2346 by 1568 pixels
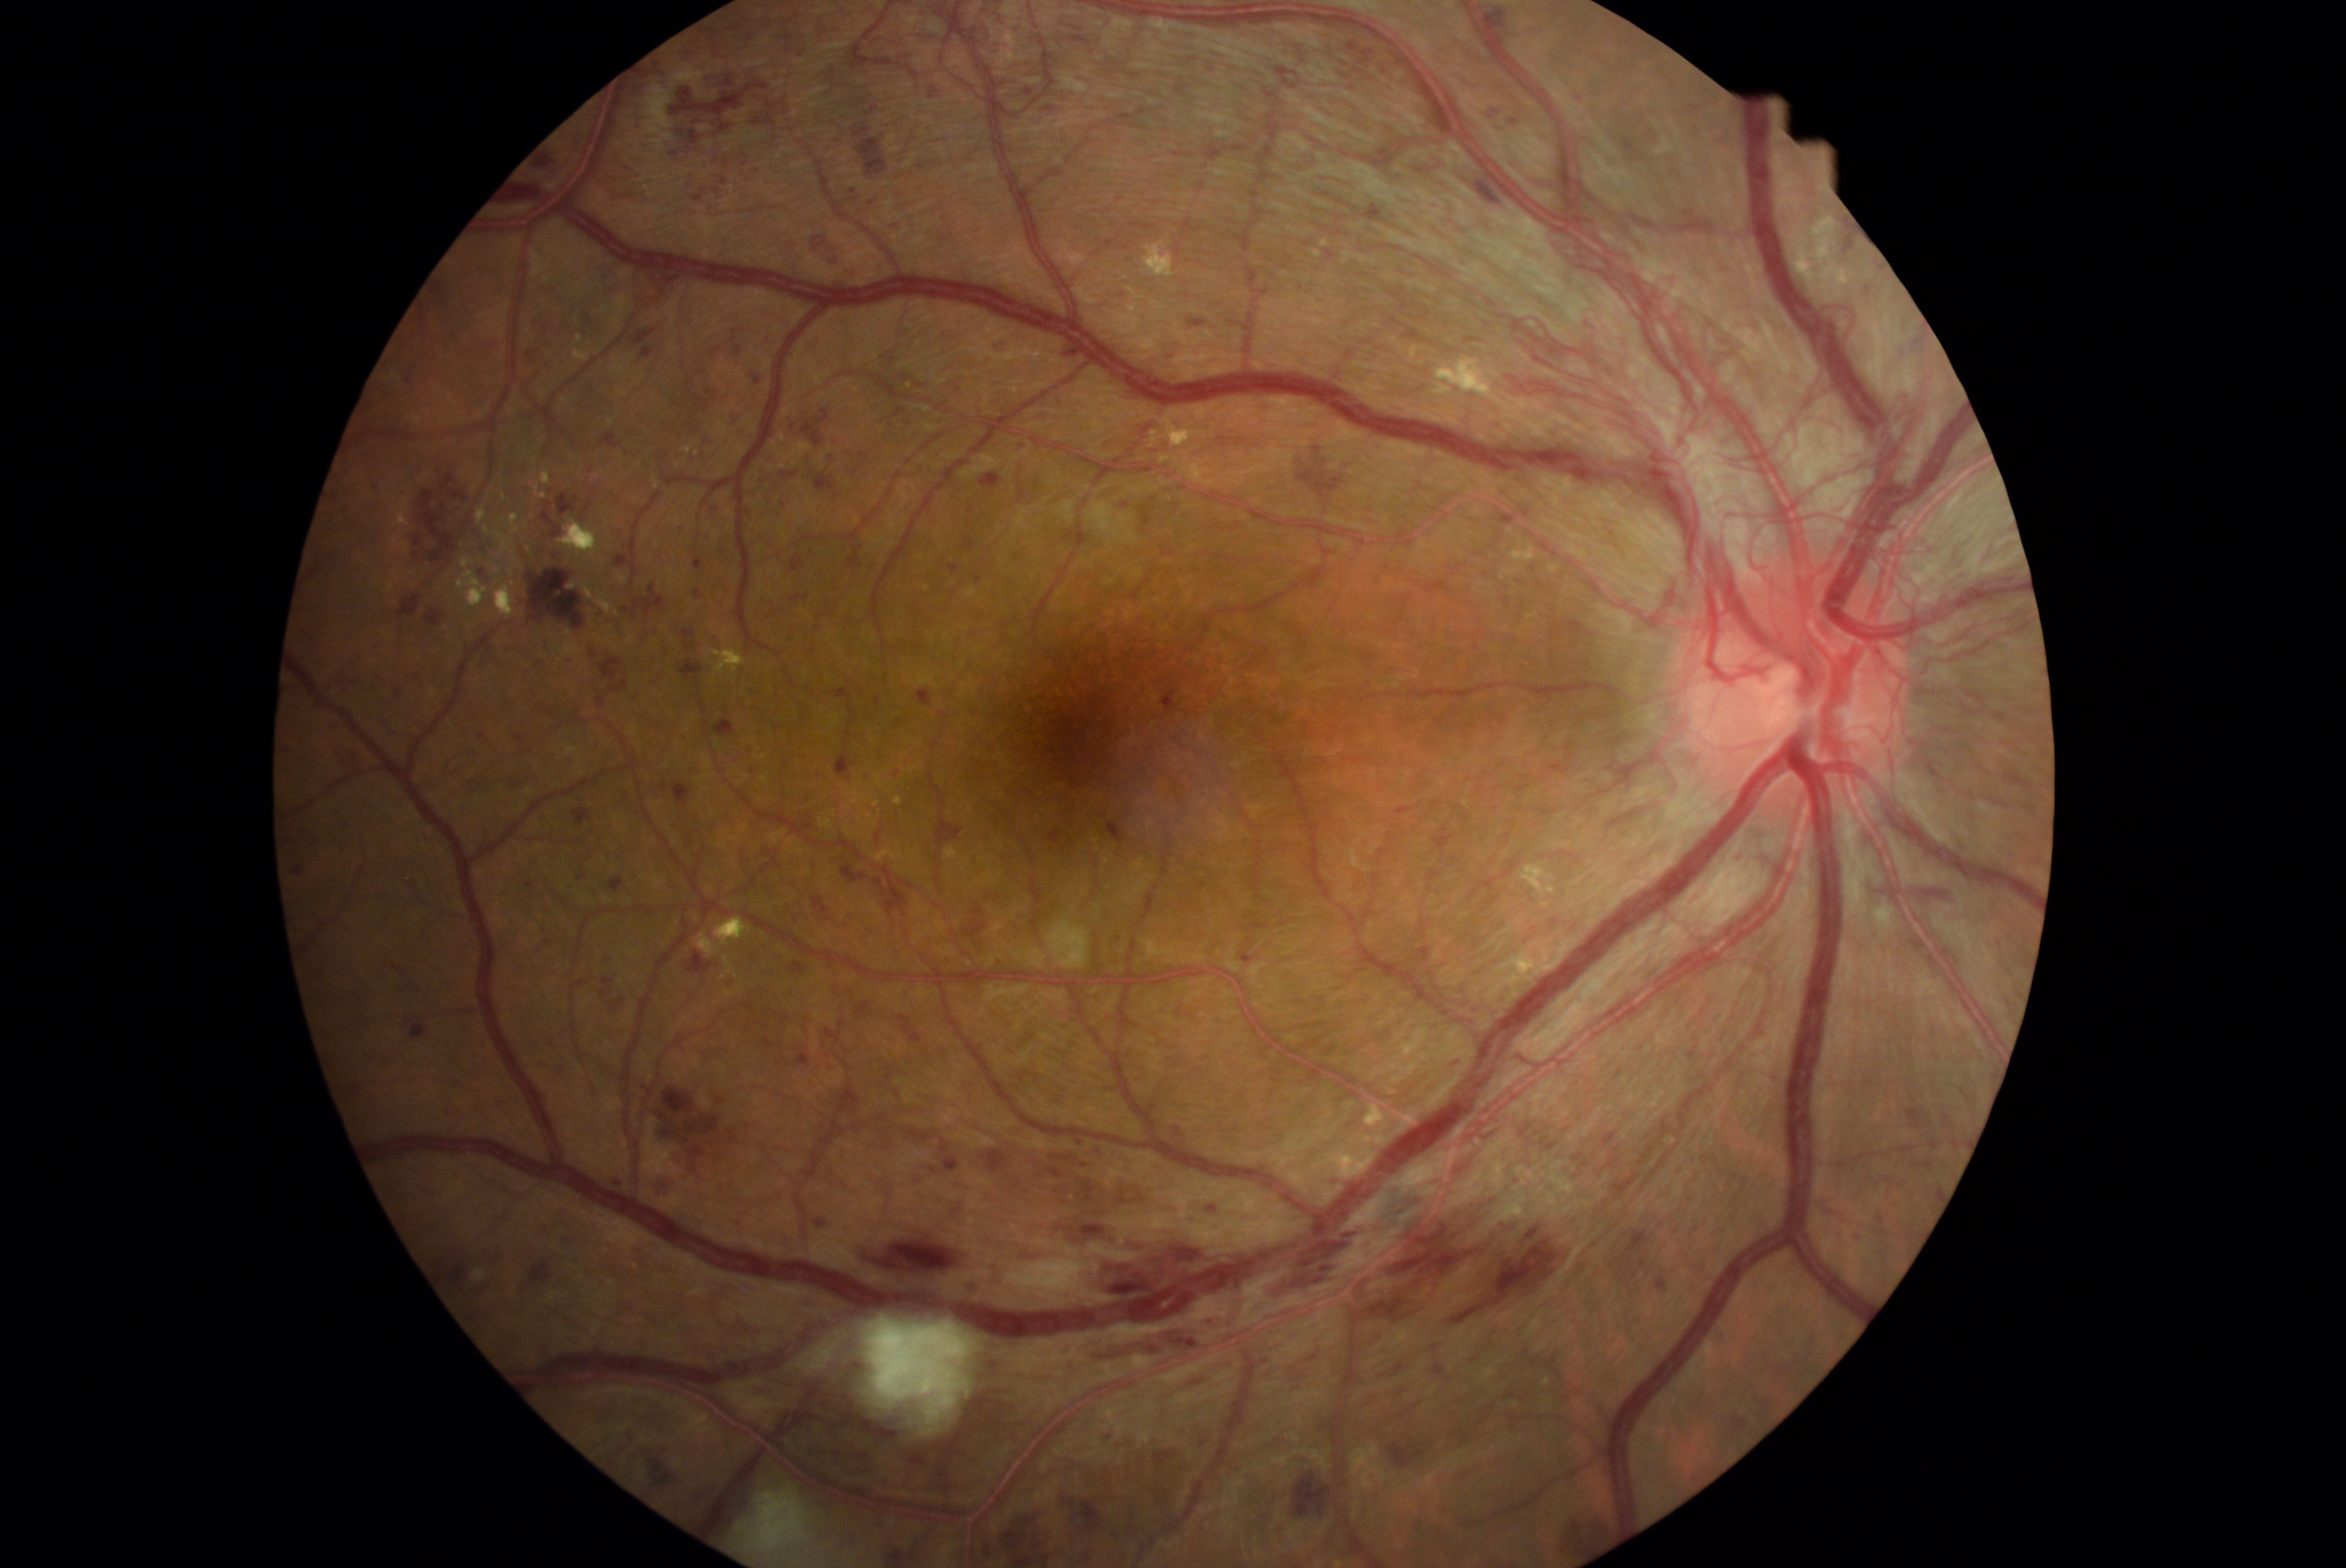 partial: true
dr_grade: 4
lesions:
  he:
    - <box>525,661,545,677</box>
    - <box>374,1054,394,1069</box>
    - <box>1726,1415,1752,1437</box>
    - <box>1928,956,1941,970</box>
    - <box>747,167,761,175</box>
    - <box>587,644,601,661</box>
    - <box>1146,438,1171,457</box>
    - <box>1238,953,1255,965</box>
    - <box>860,452,870,460</box>
    - <box>573,981,587,987</box>
    - <box>956,1280,976,1299</box>
    - <box>1028,1034,1036,1039</box>
    - <box>1061,1494,1108,1537</box>
    - <box>488,1329,525,1362</box>
    - <box>451,1122,462,1134</box>
    - <box>821,1117,848,1147</box>
    - <box>840,863,912,921</box>
    - <box>528,882,534,890</box>
  he_small:
    - pt(1080, 1143)